Pediatric retinal photograph (wide-field); captured with the Phoenix ICON (100° field of view); 1240x1240.
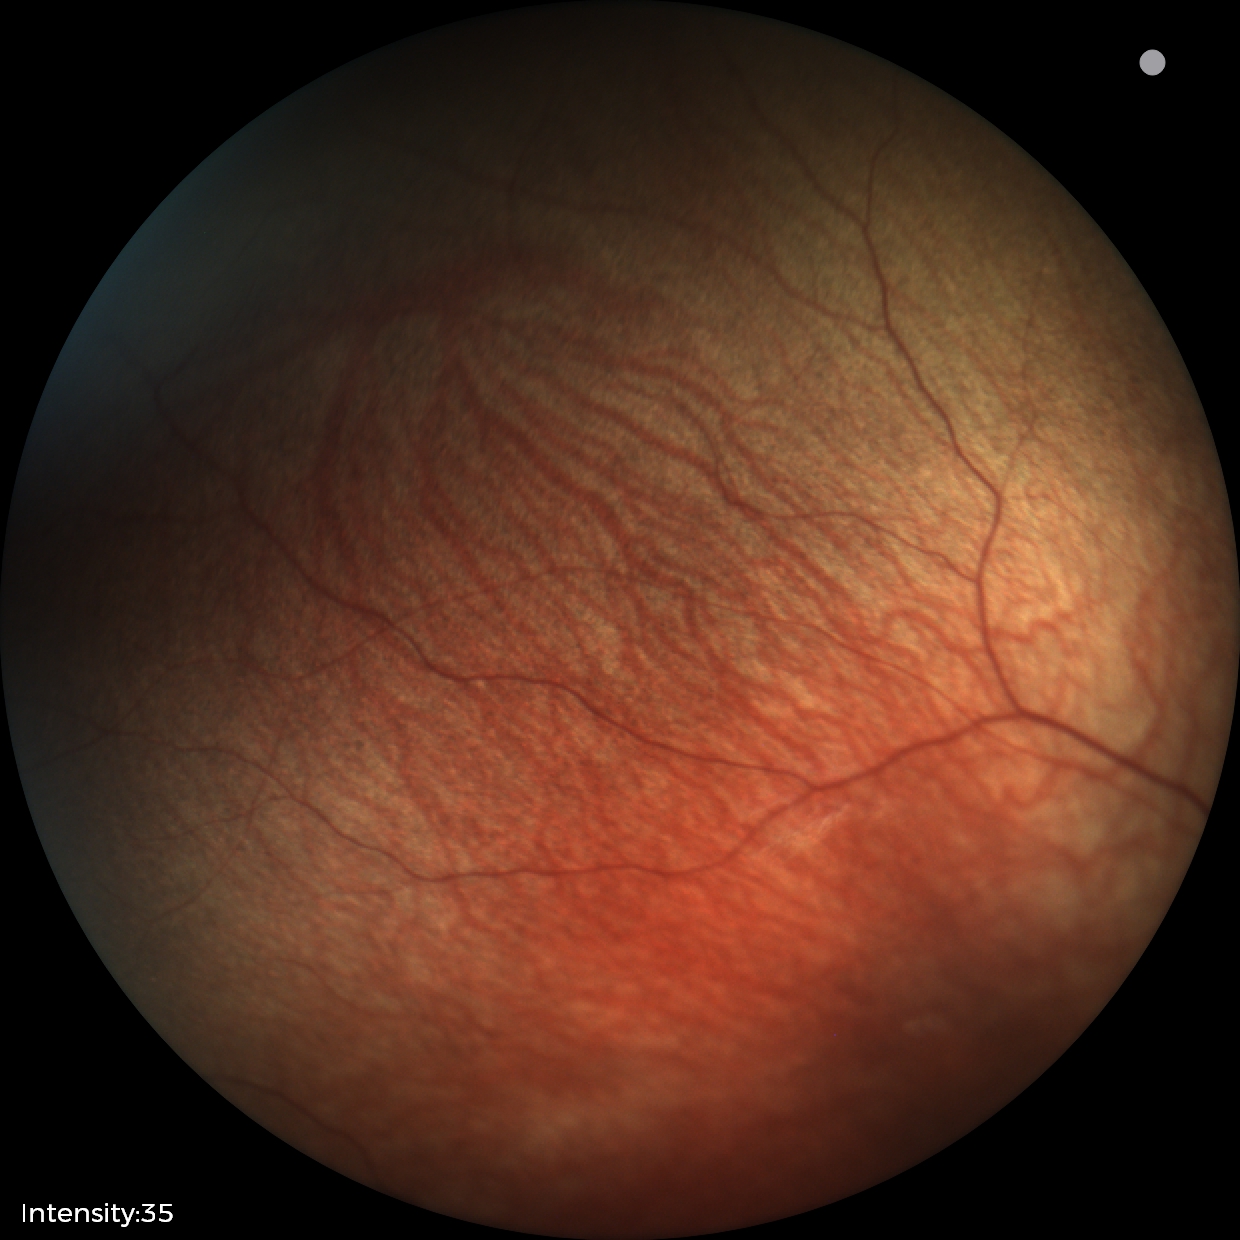 Physiological retinal appearance for postconceptual age.